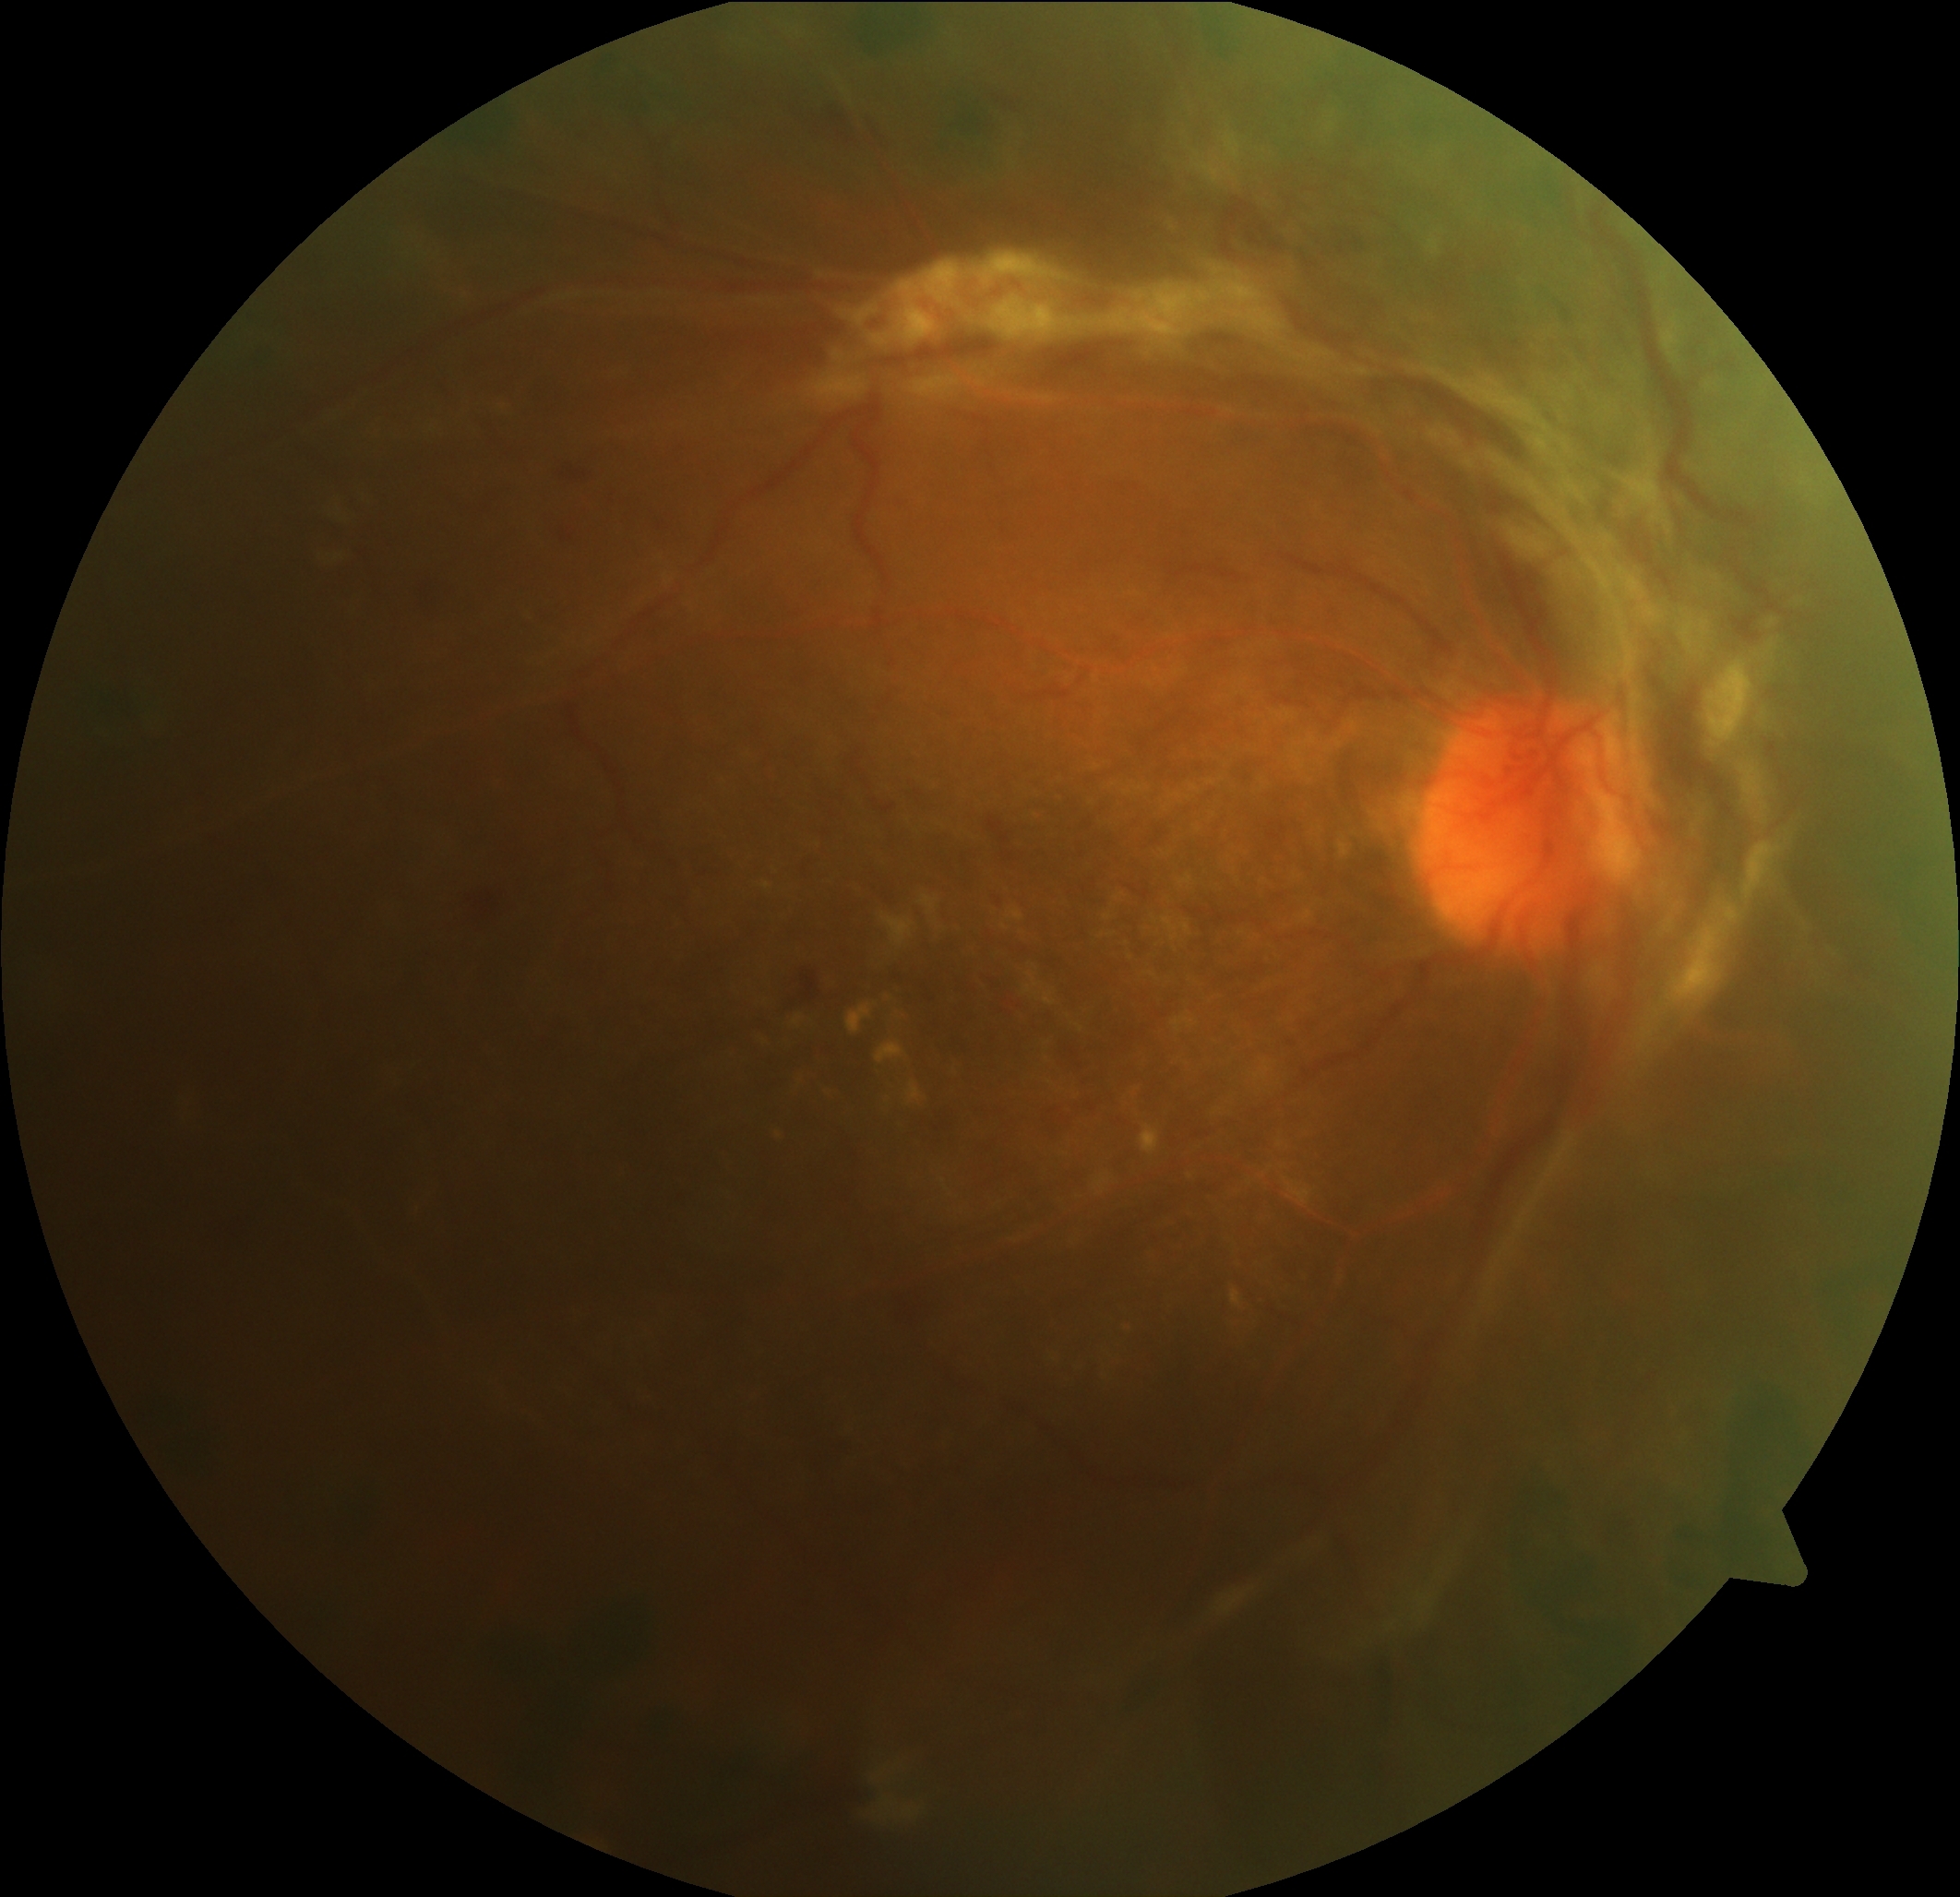 DR grade=4.